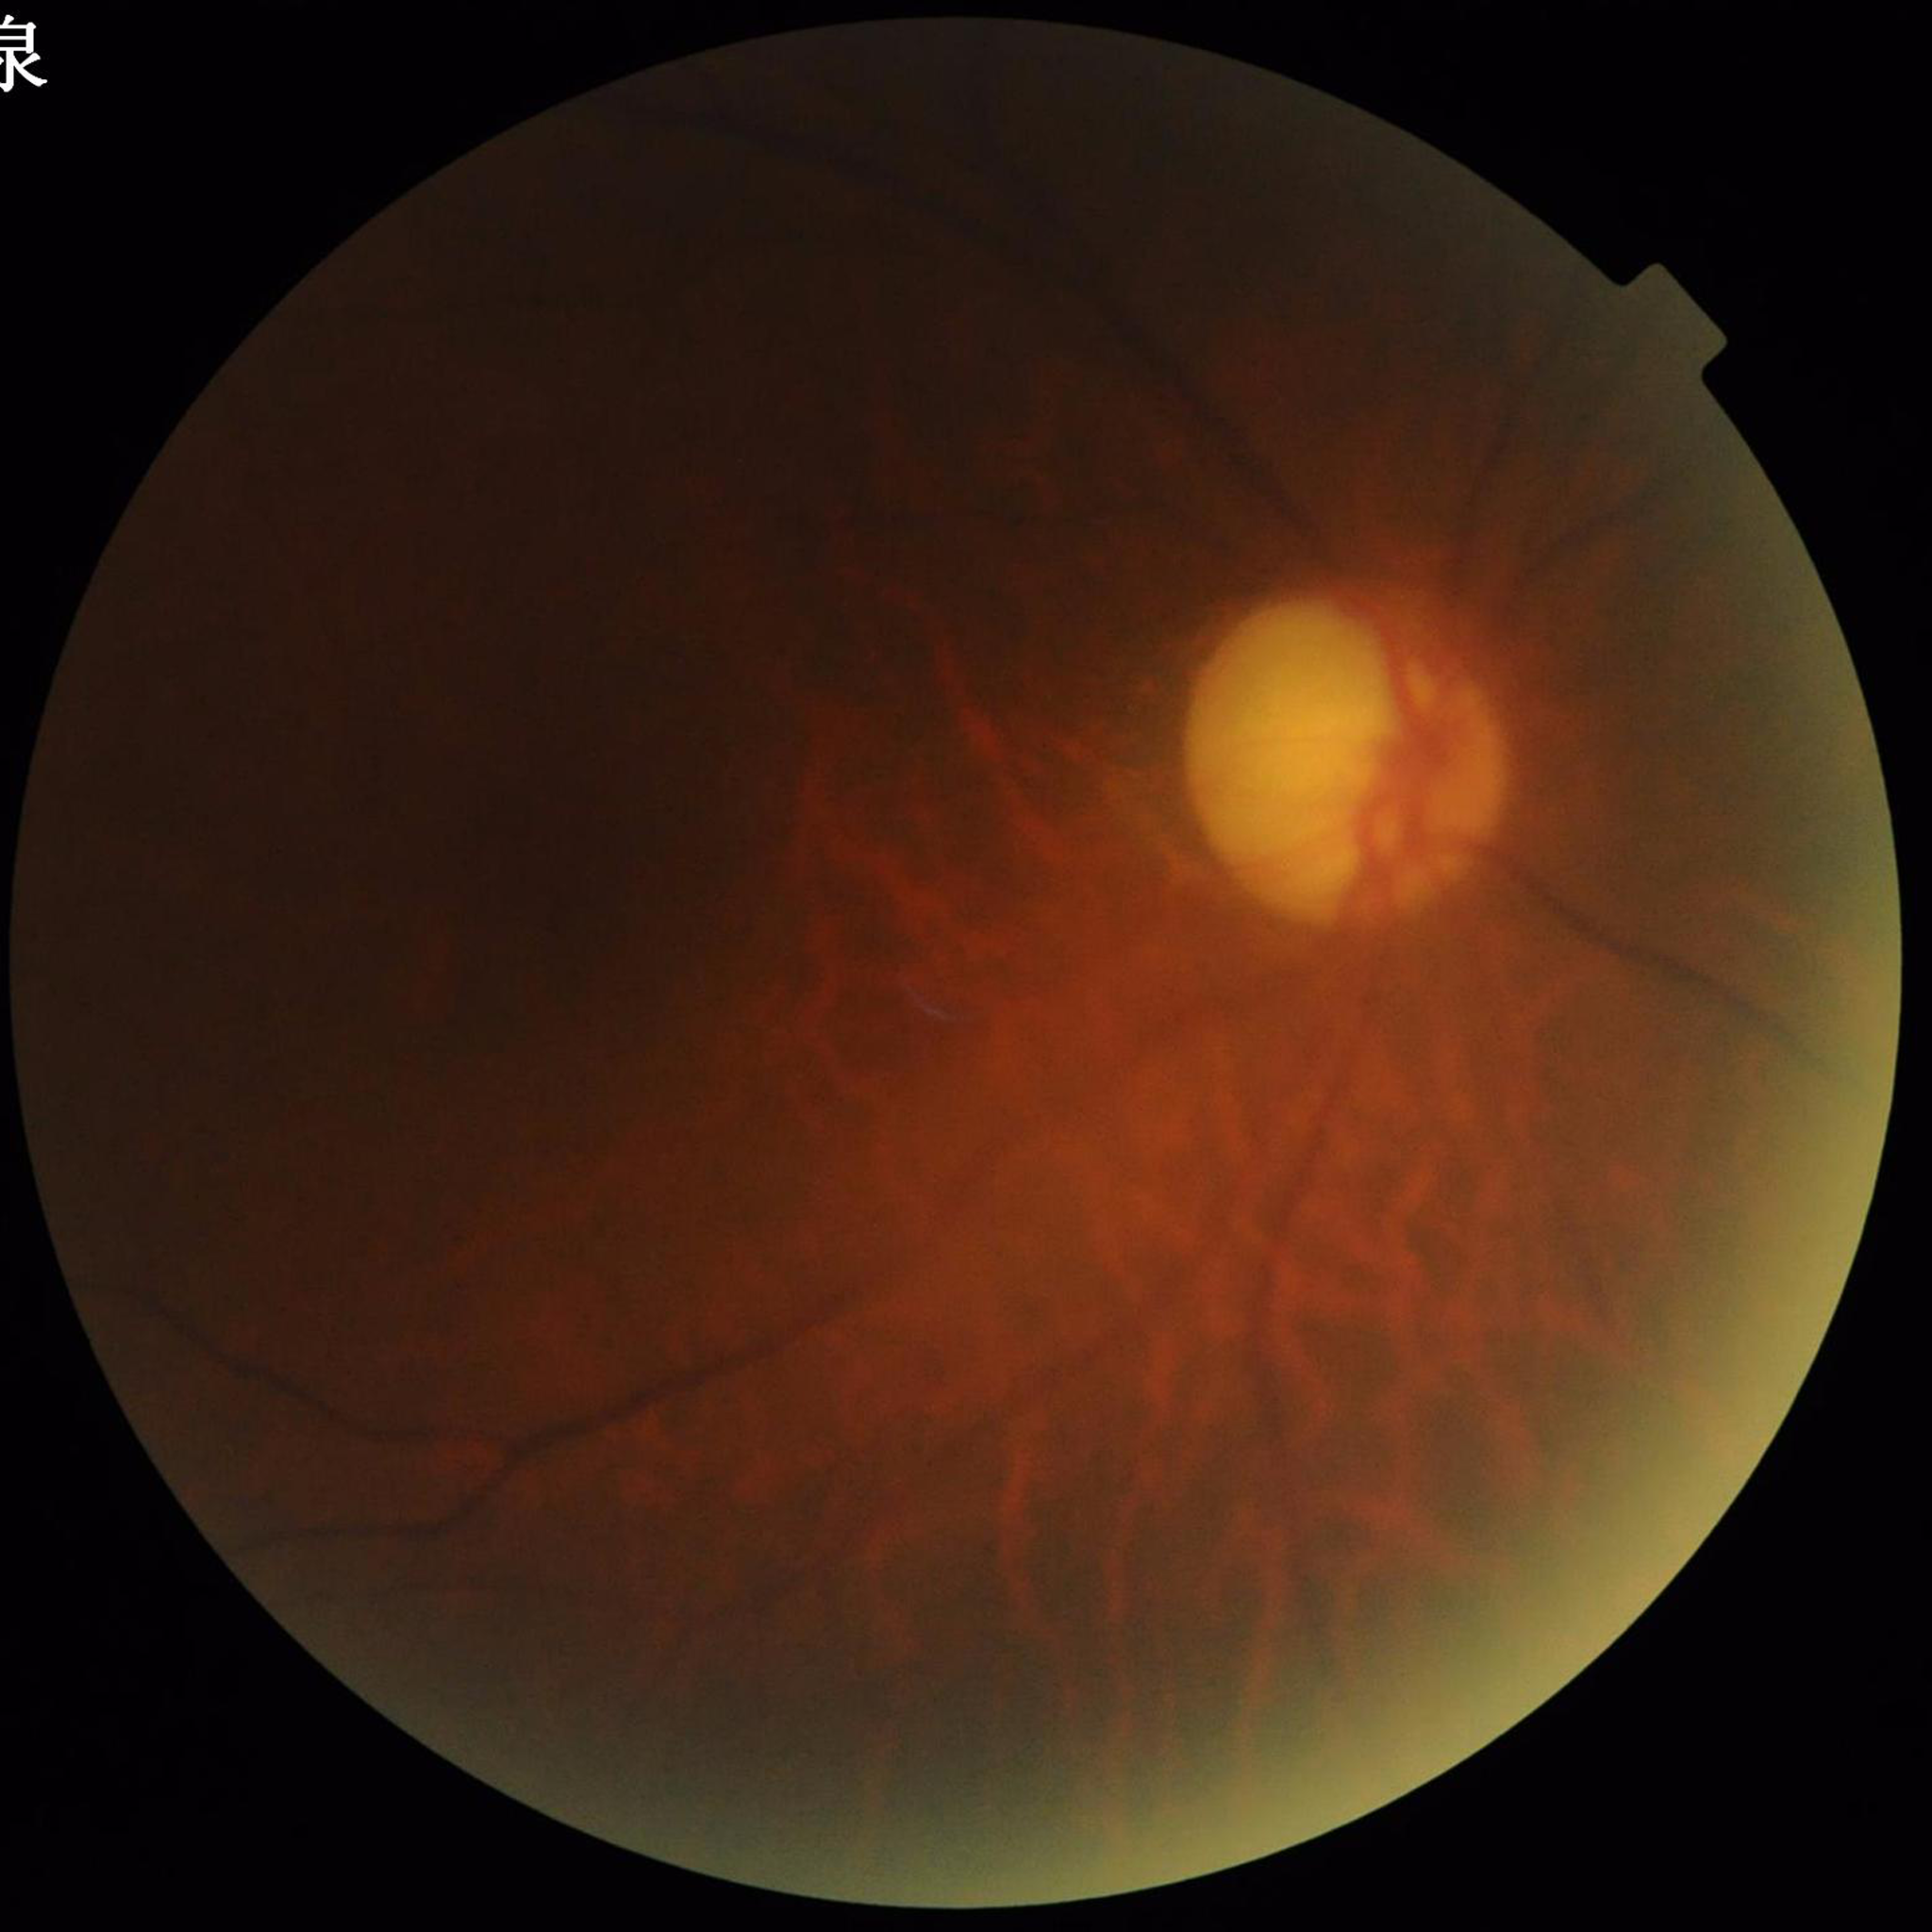

Diagnosed with glaucoma.